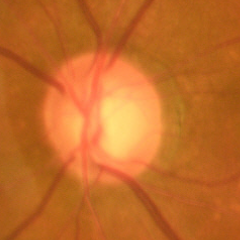
Findings consistent with glaucoma. Assessment = early glaucomatous changes.